45° field of view. Fundus photo:
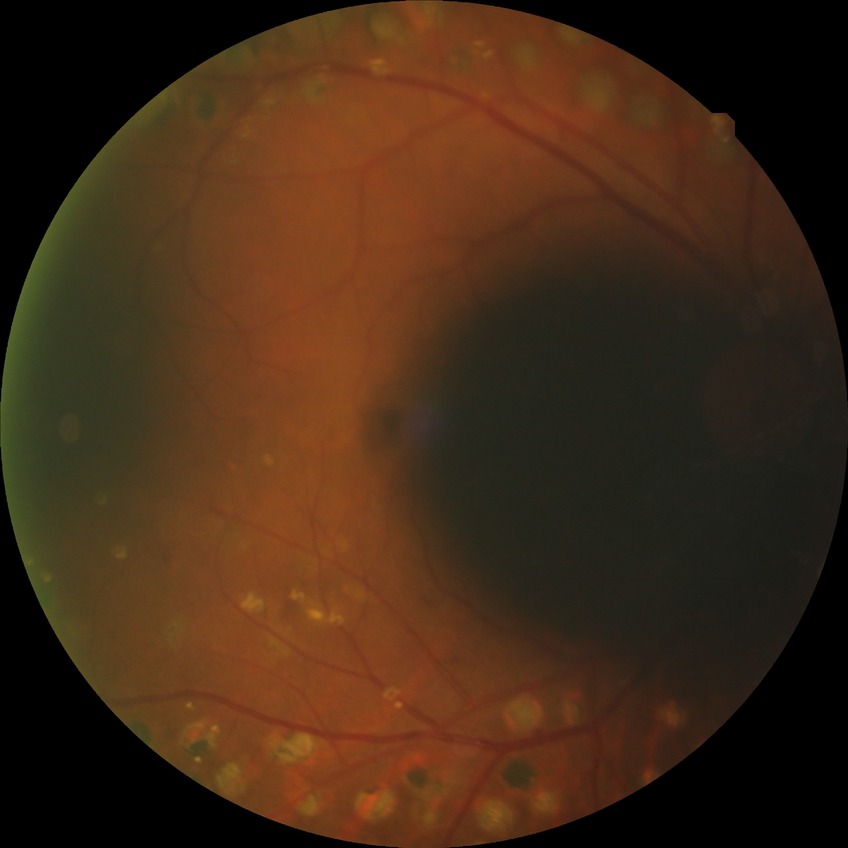

Diabetic retinopathy (DR): proliferative diabetic retinopathy (PDR).